2352x1568.
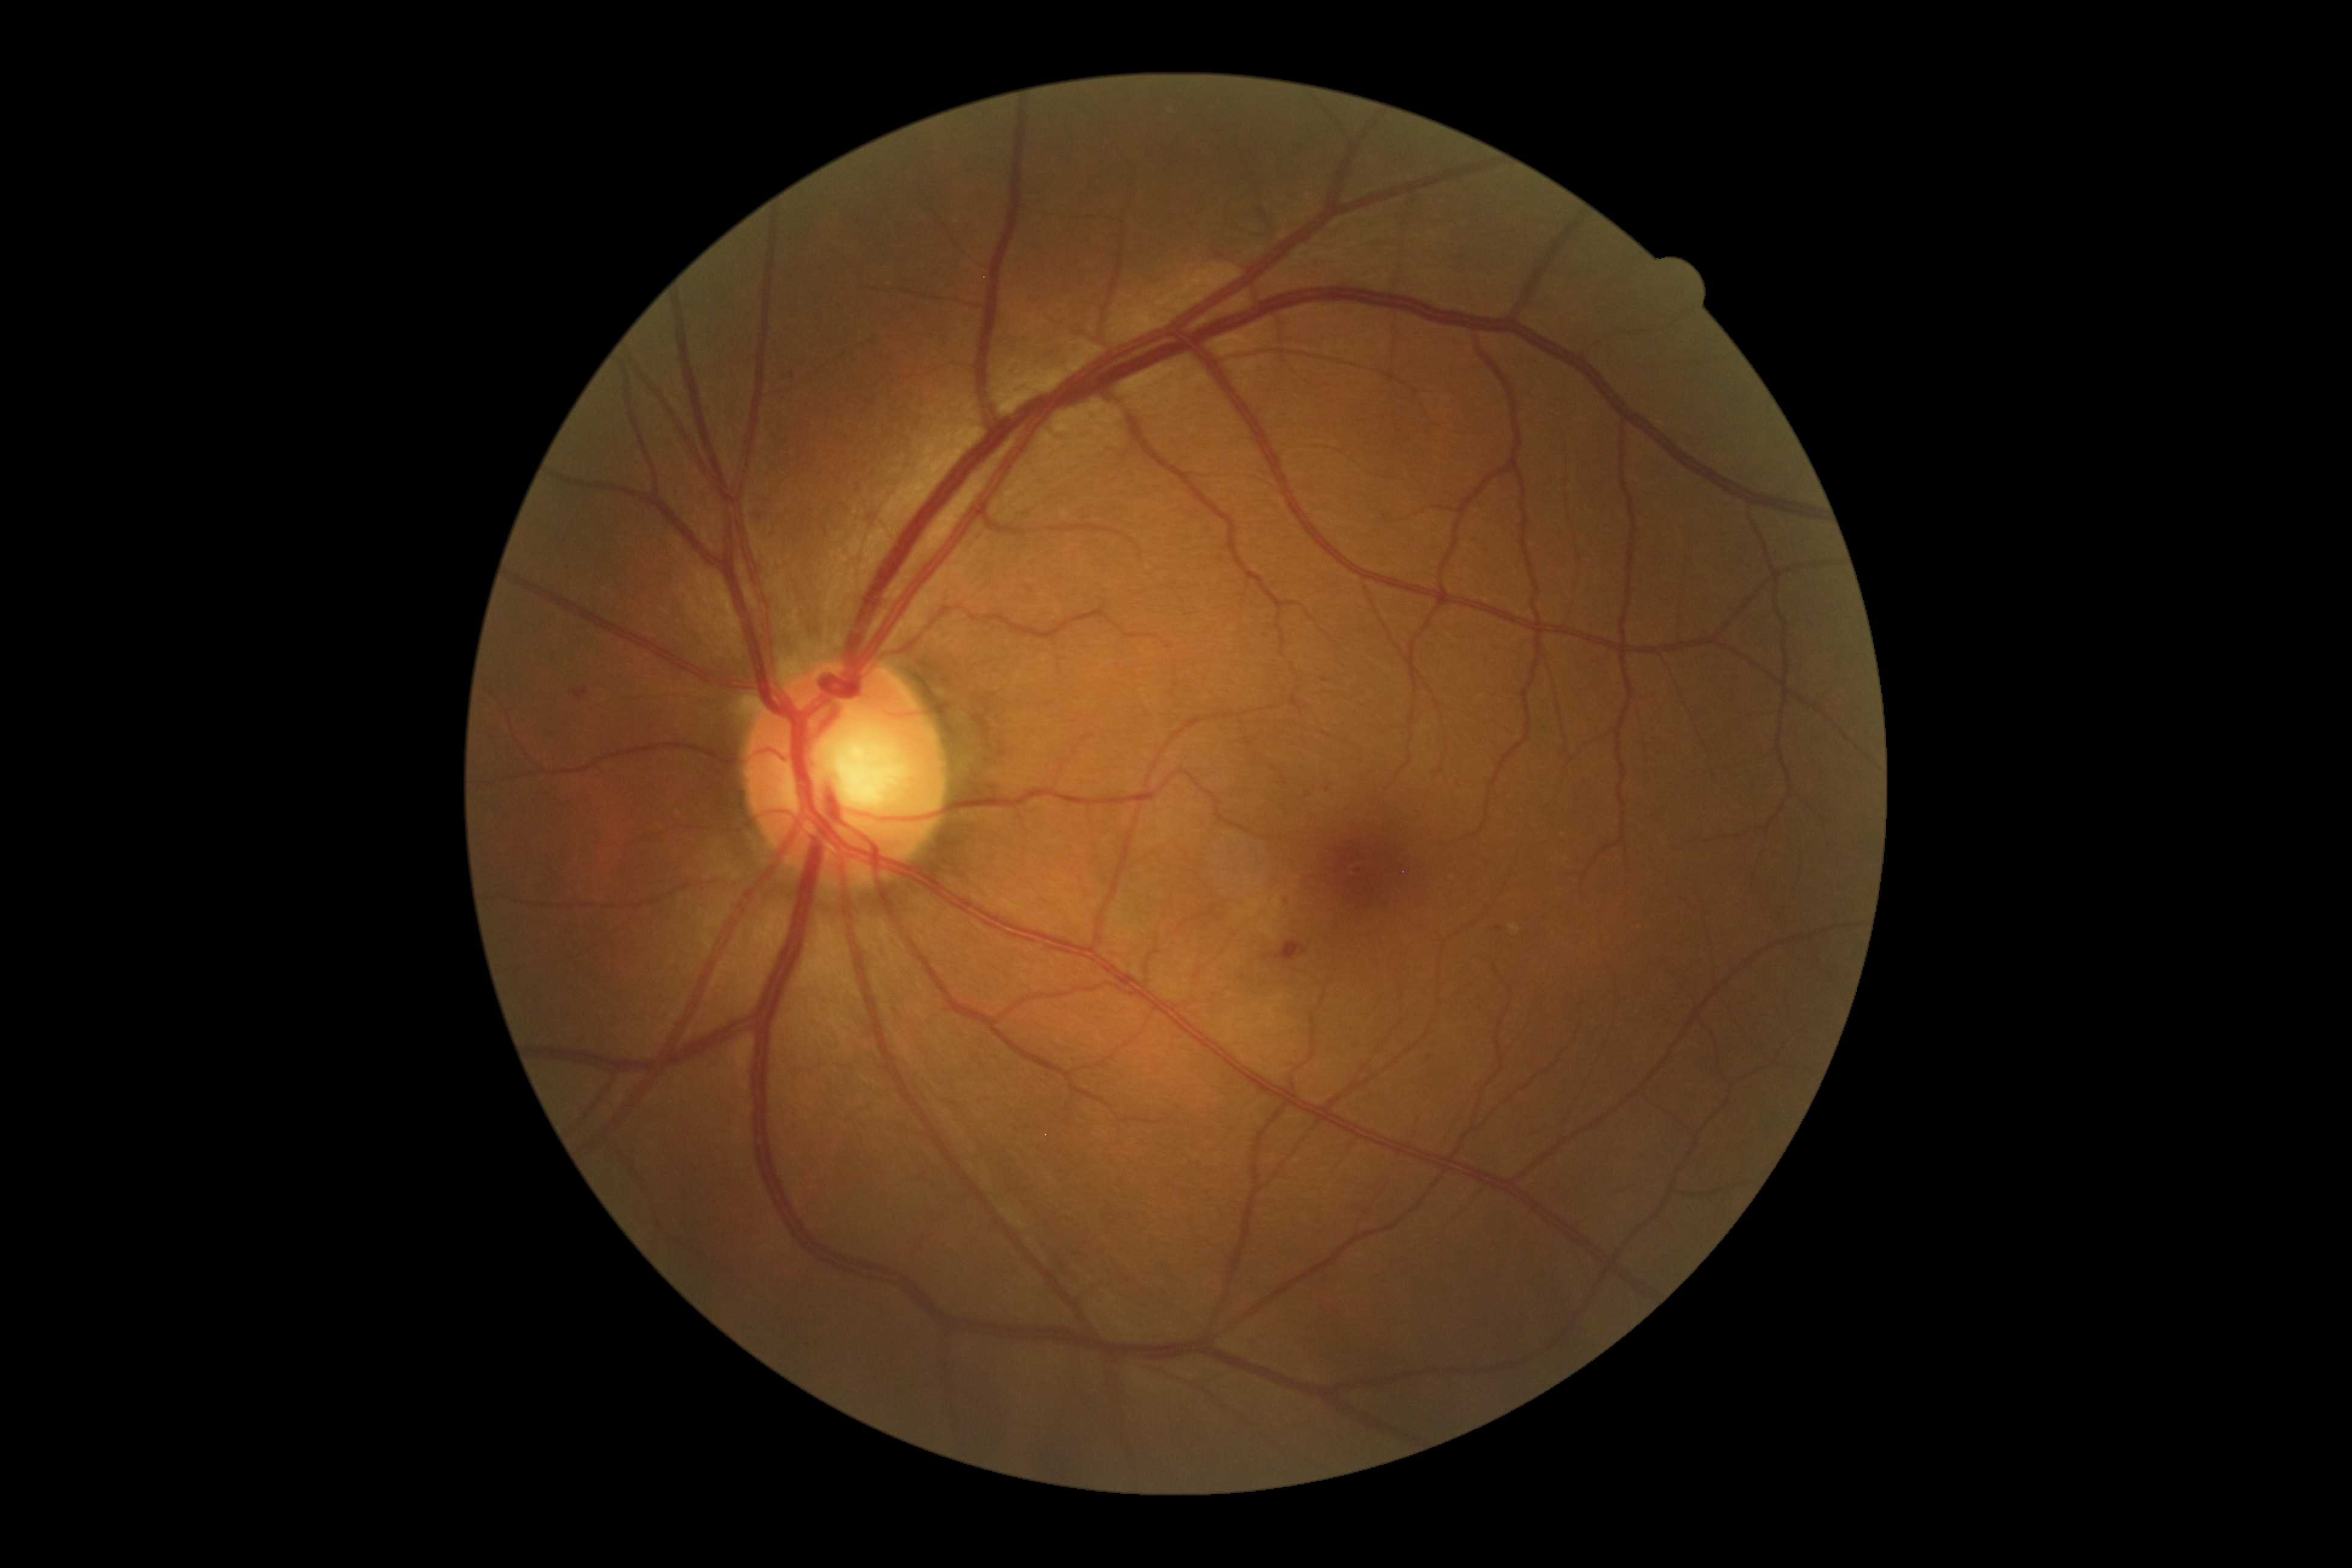
DR class = non-proliferative diabetic retinopathy
DR = grade 2 (moderate NPDR)